NIDEK AFC-230 fundus camera · FOV: 45 degrees · image size 848x848: 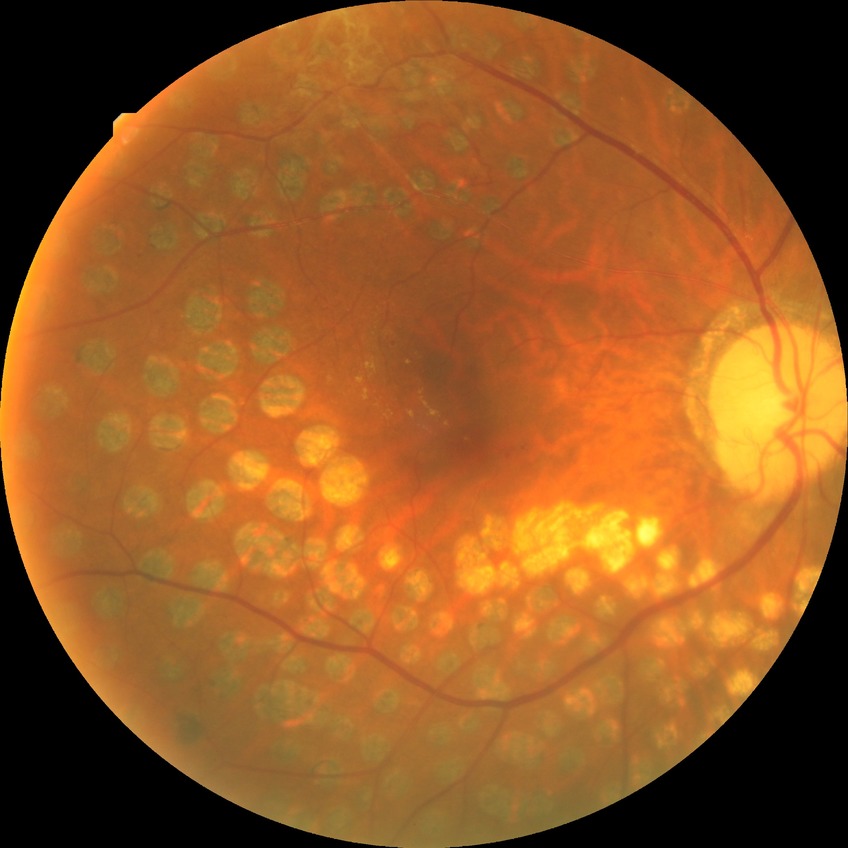 * diabetic retinopathy (DR): proliferative diabetic retinopathy (PDR)